2089x1764px: 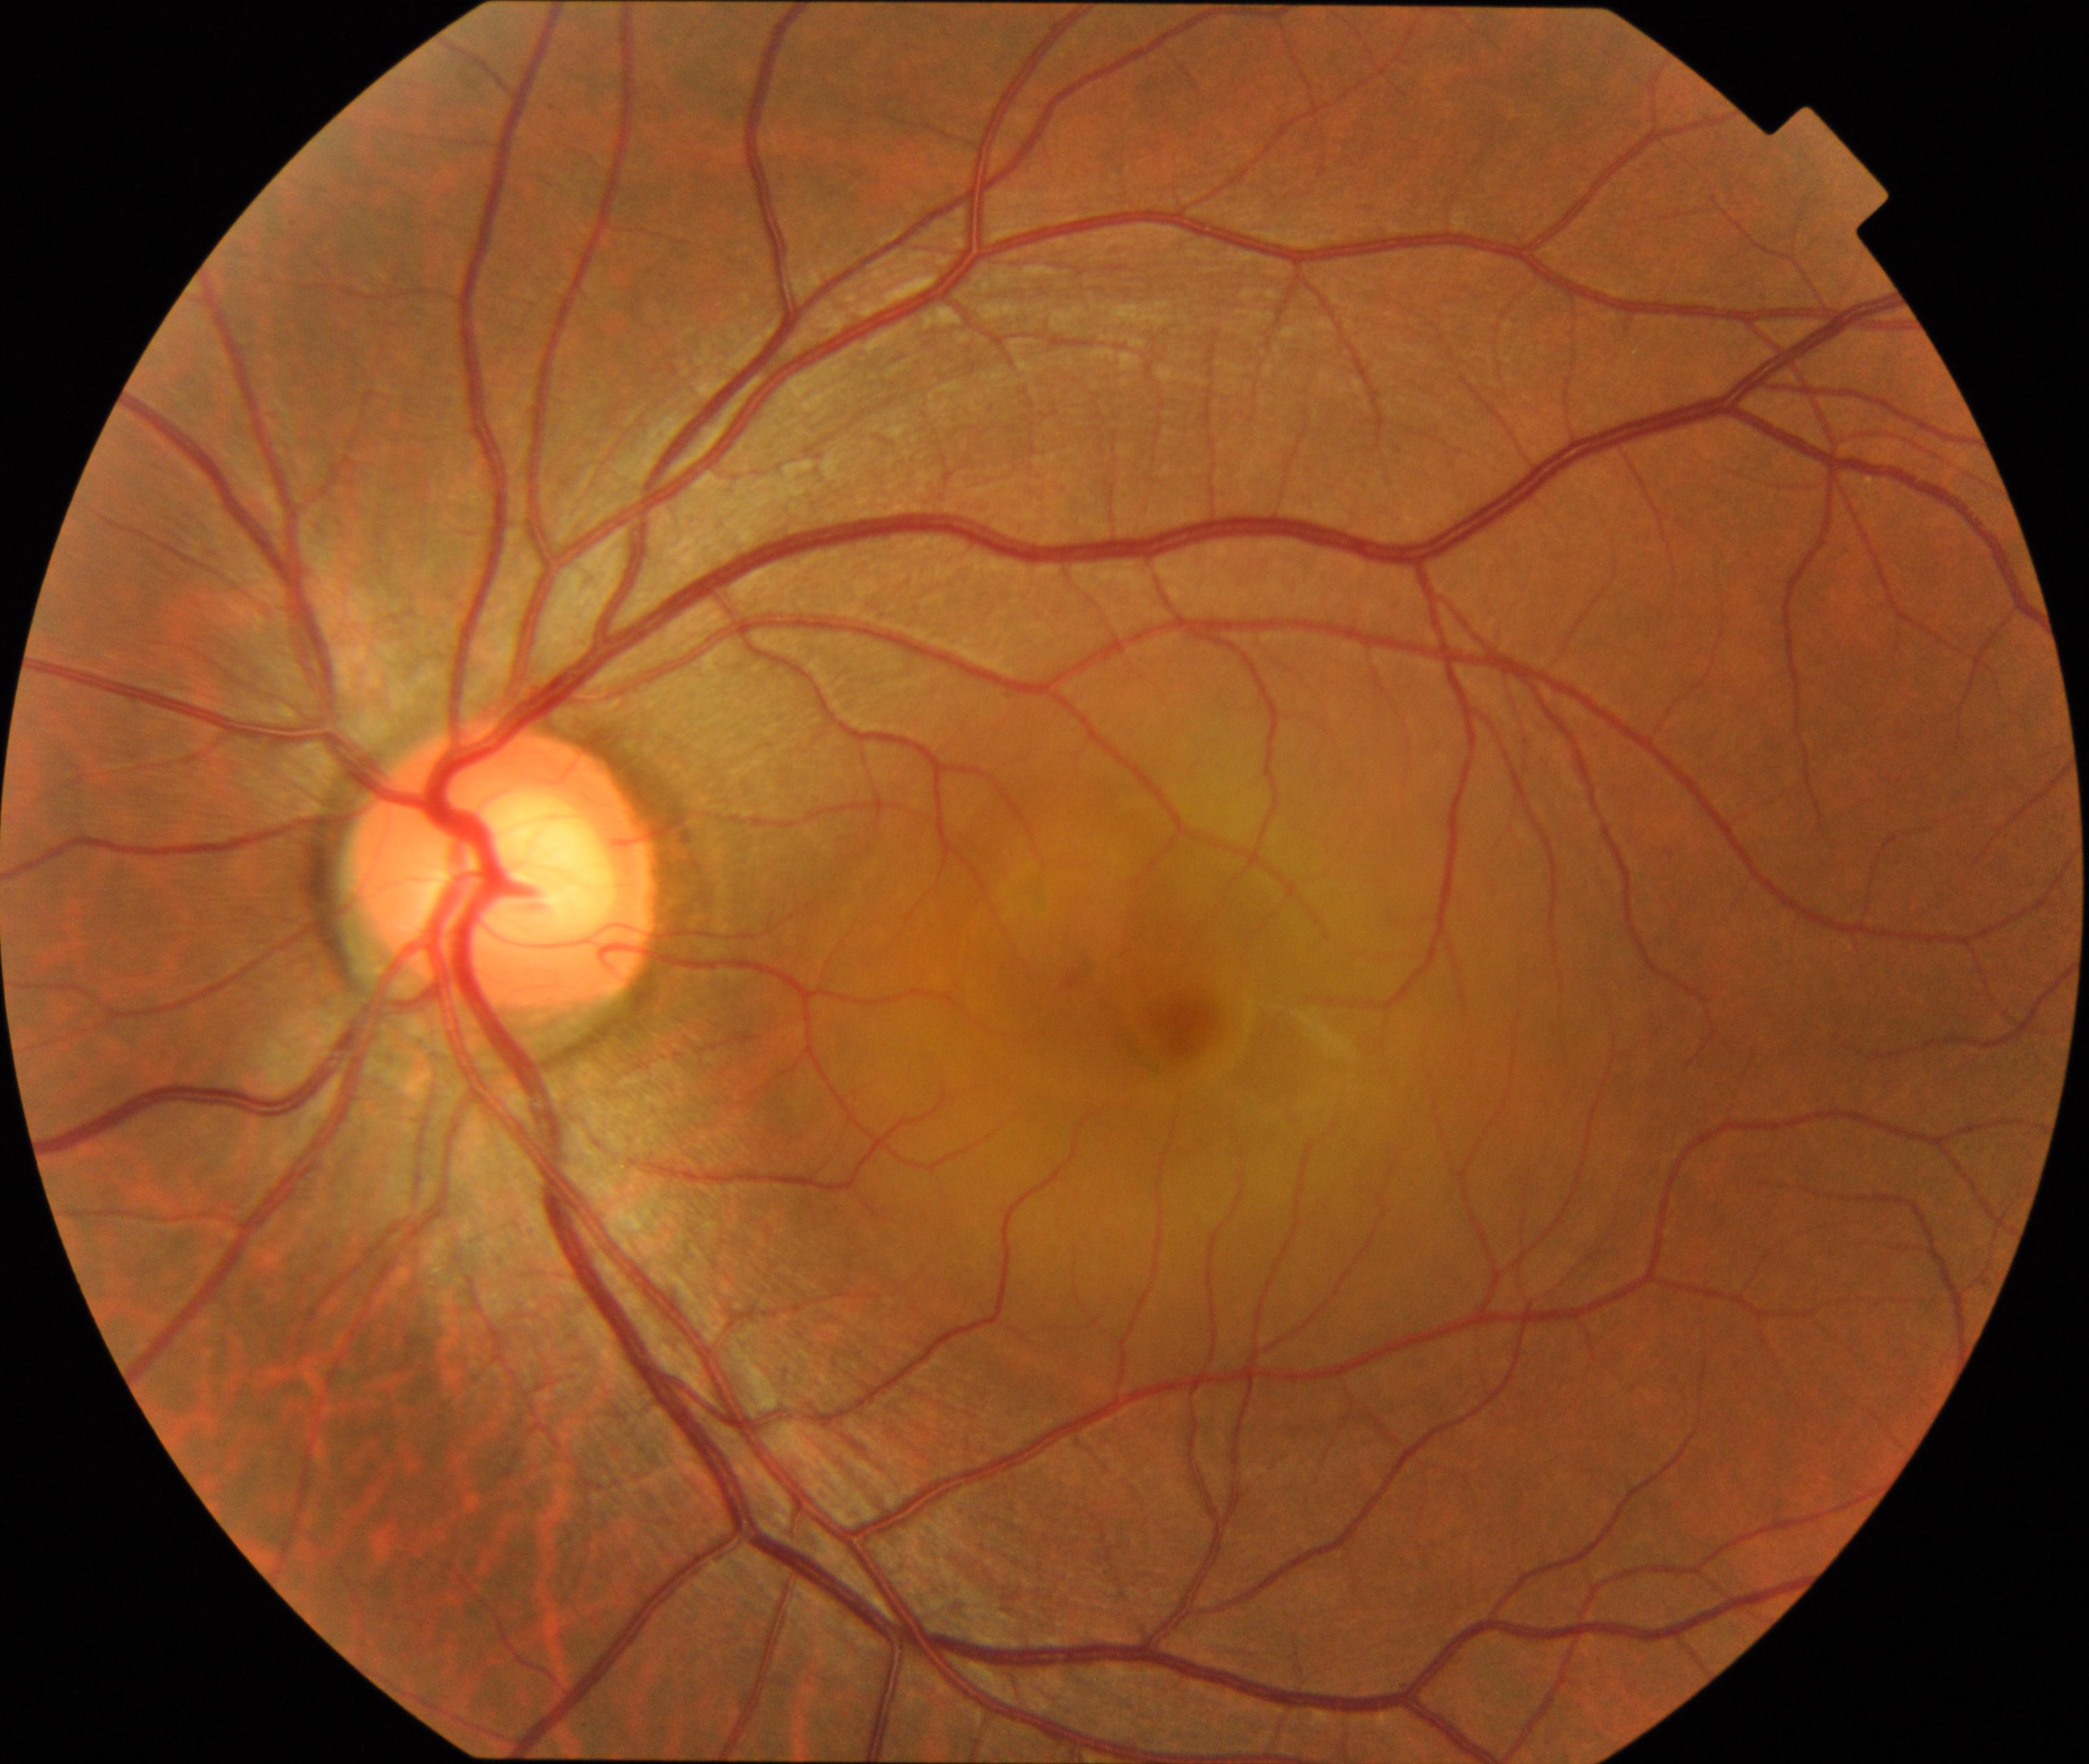

Diagnosis: central serous chorioretinopathy (CSCR).